Acquired with a NIDEK AFC-230: 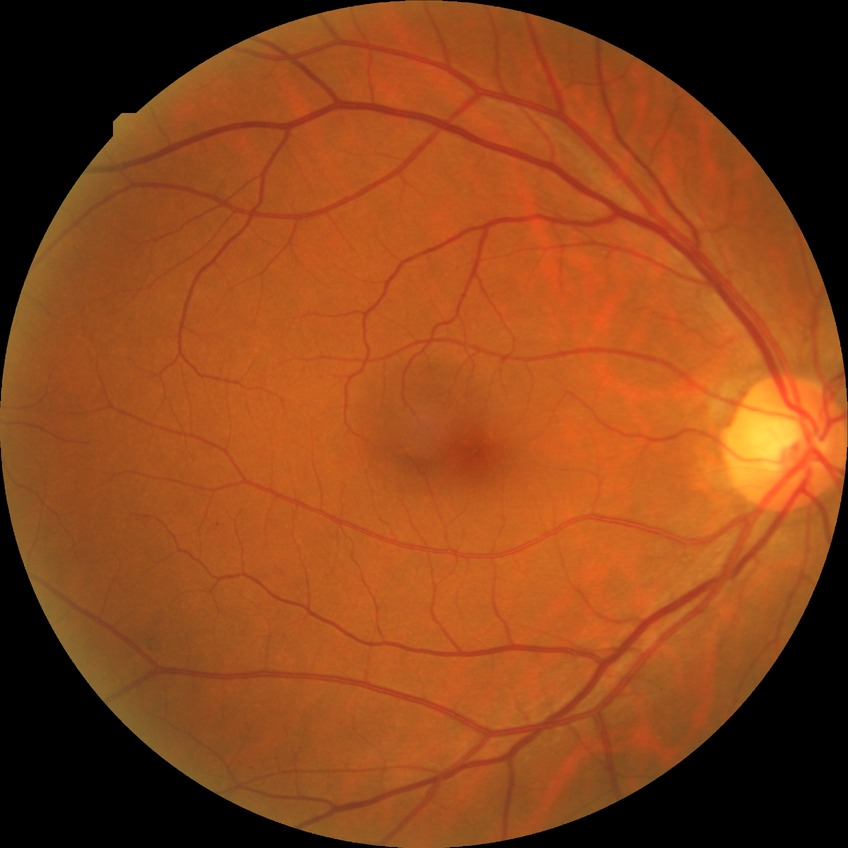
Davis grading is no diabetic retinopathy.